Acquired with a Topcon TRC-NW8: 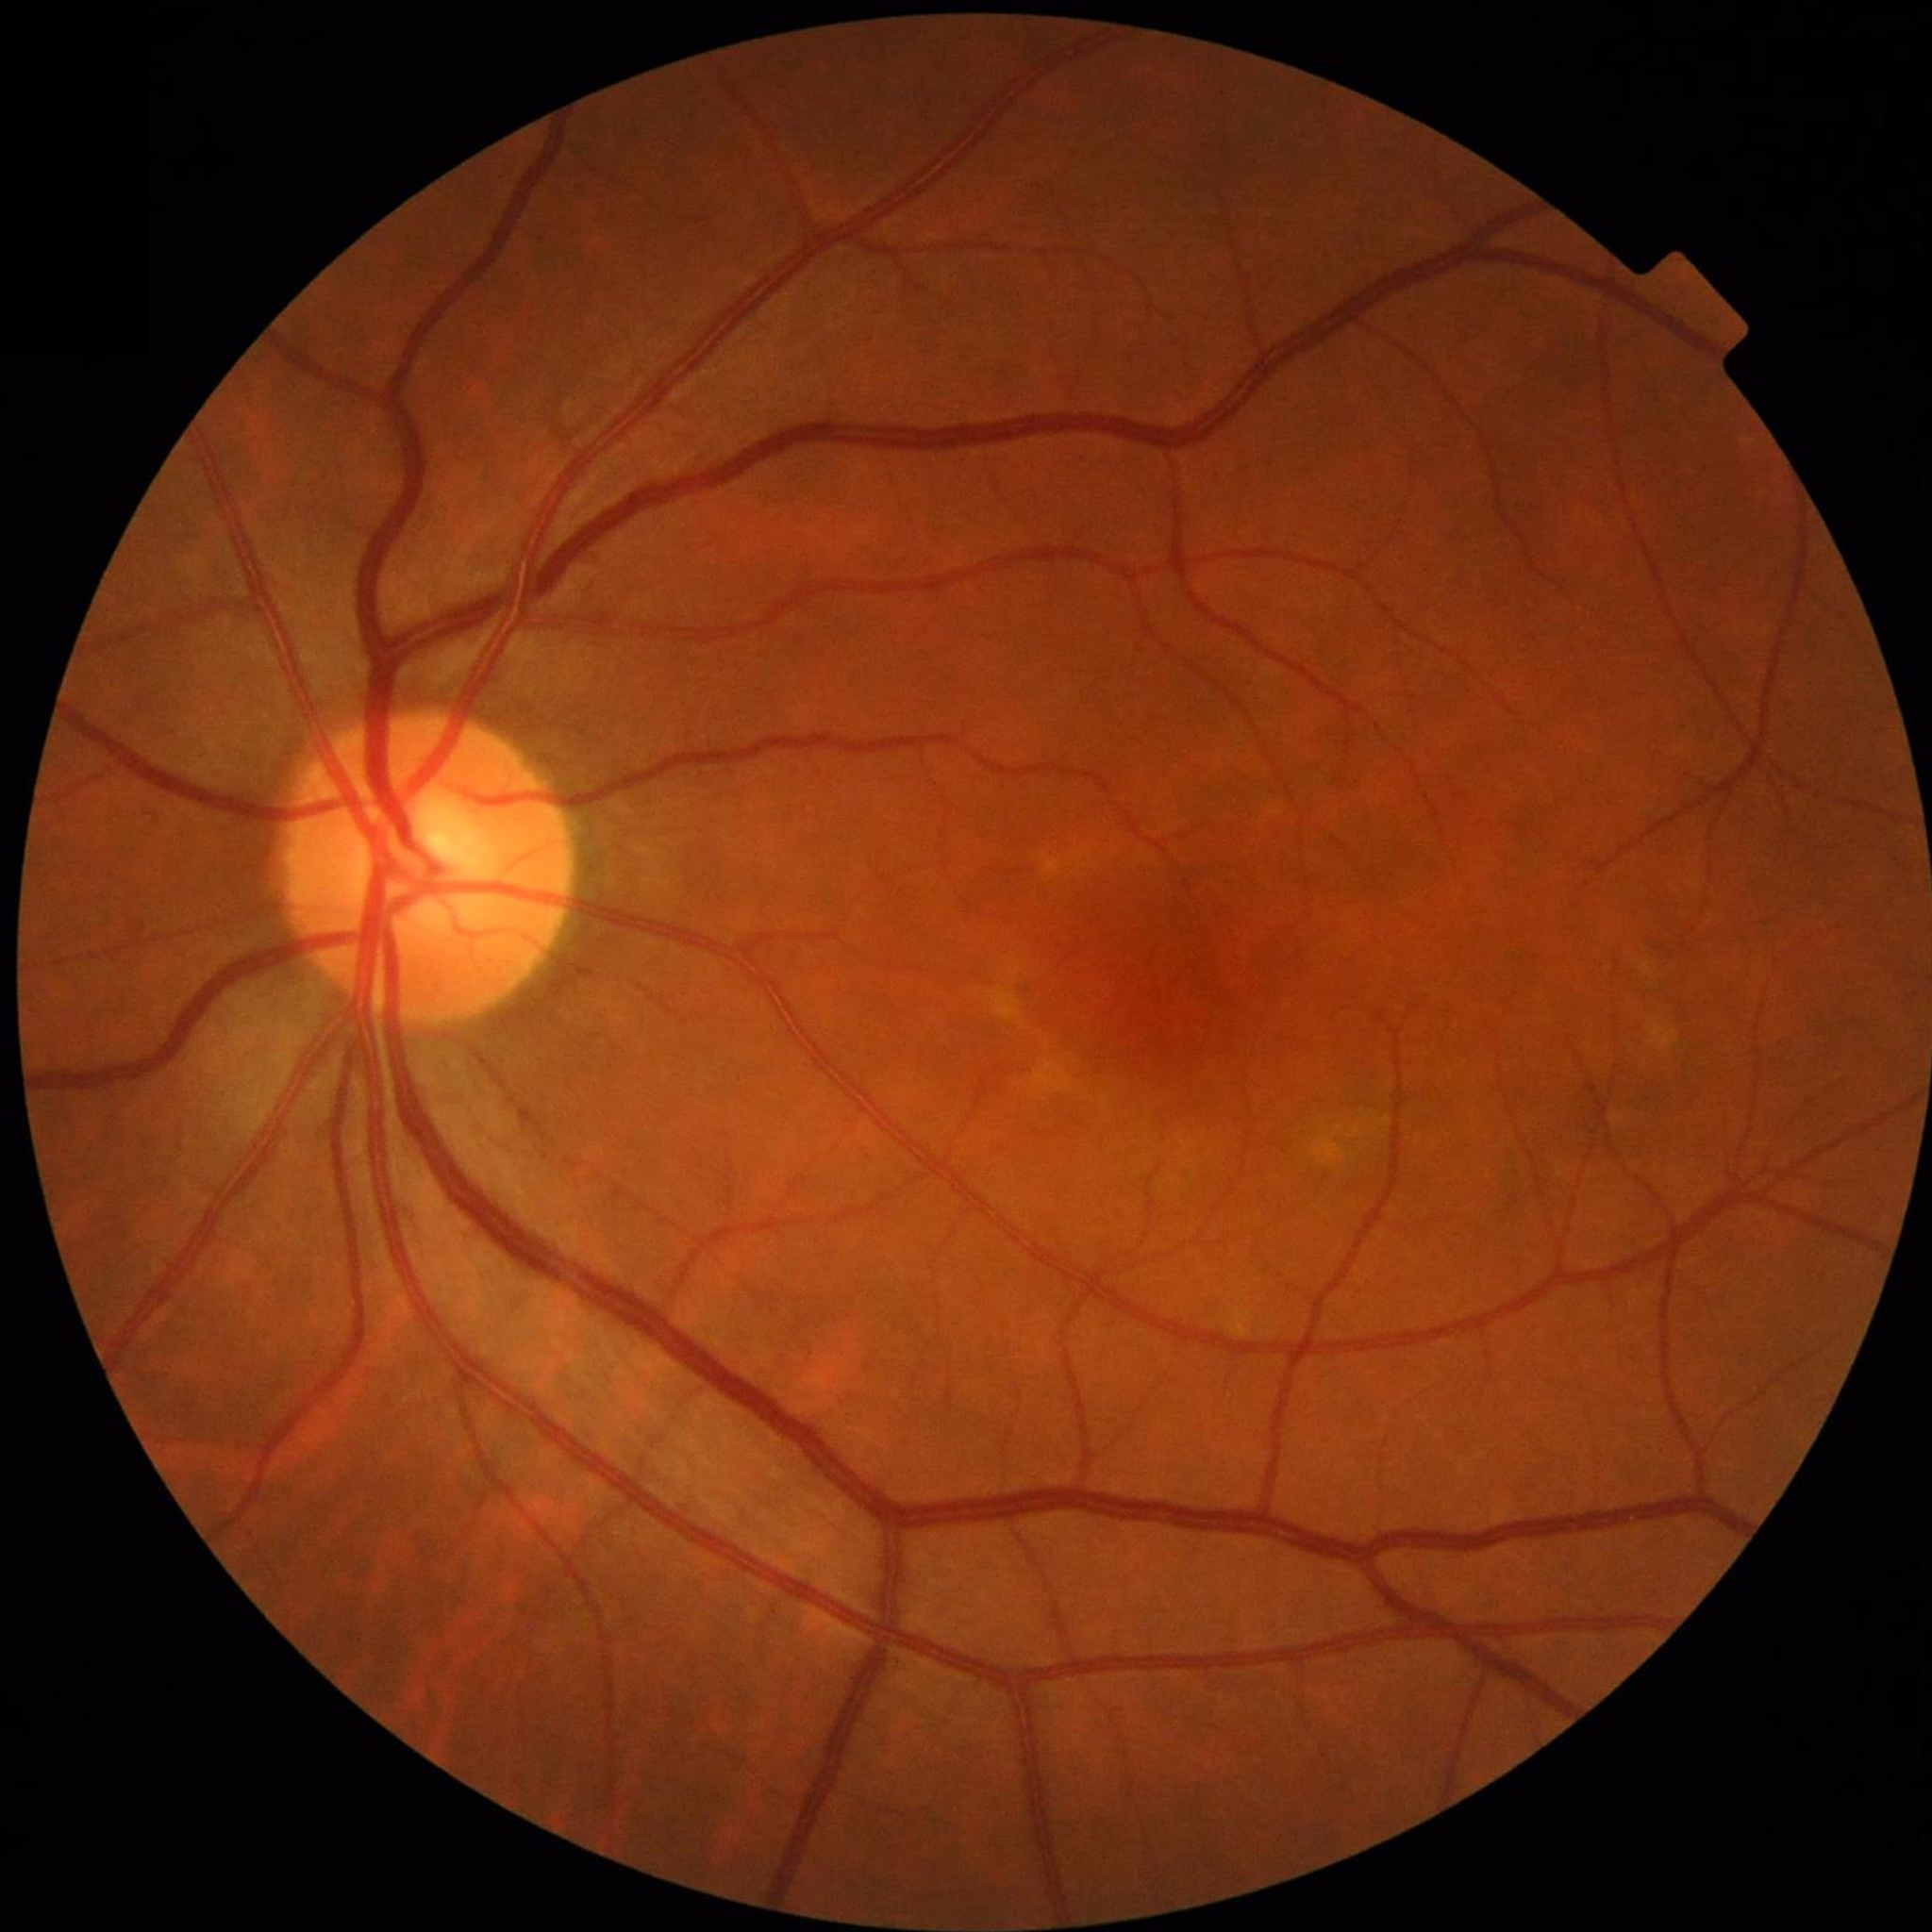
Retinal fundus photograph from a control without AMD, DR, or glaucoma.